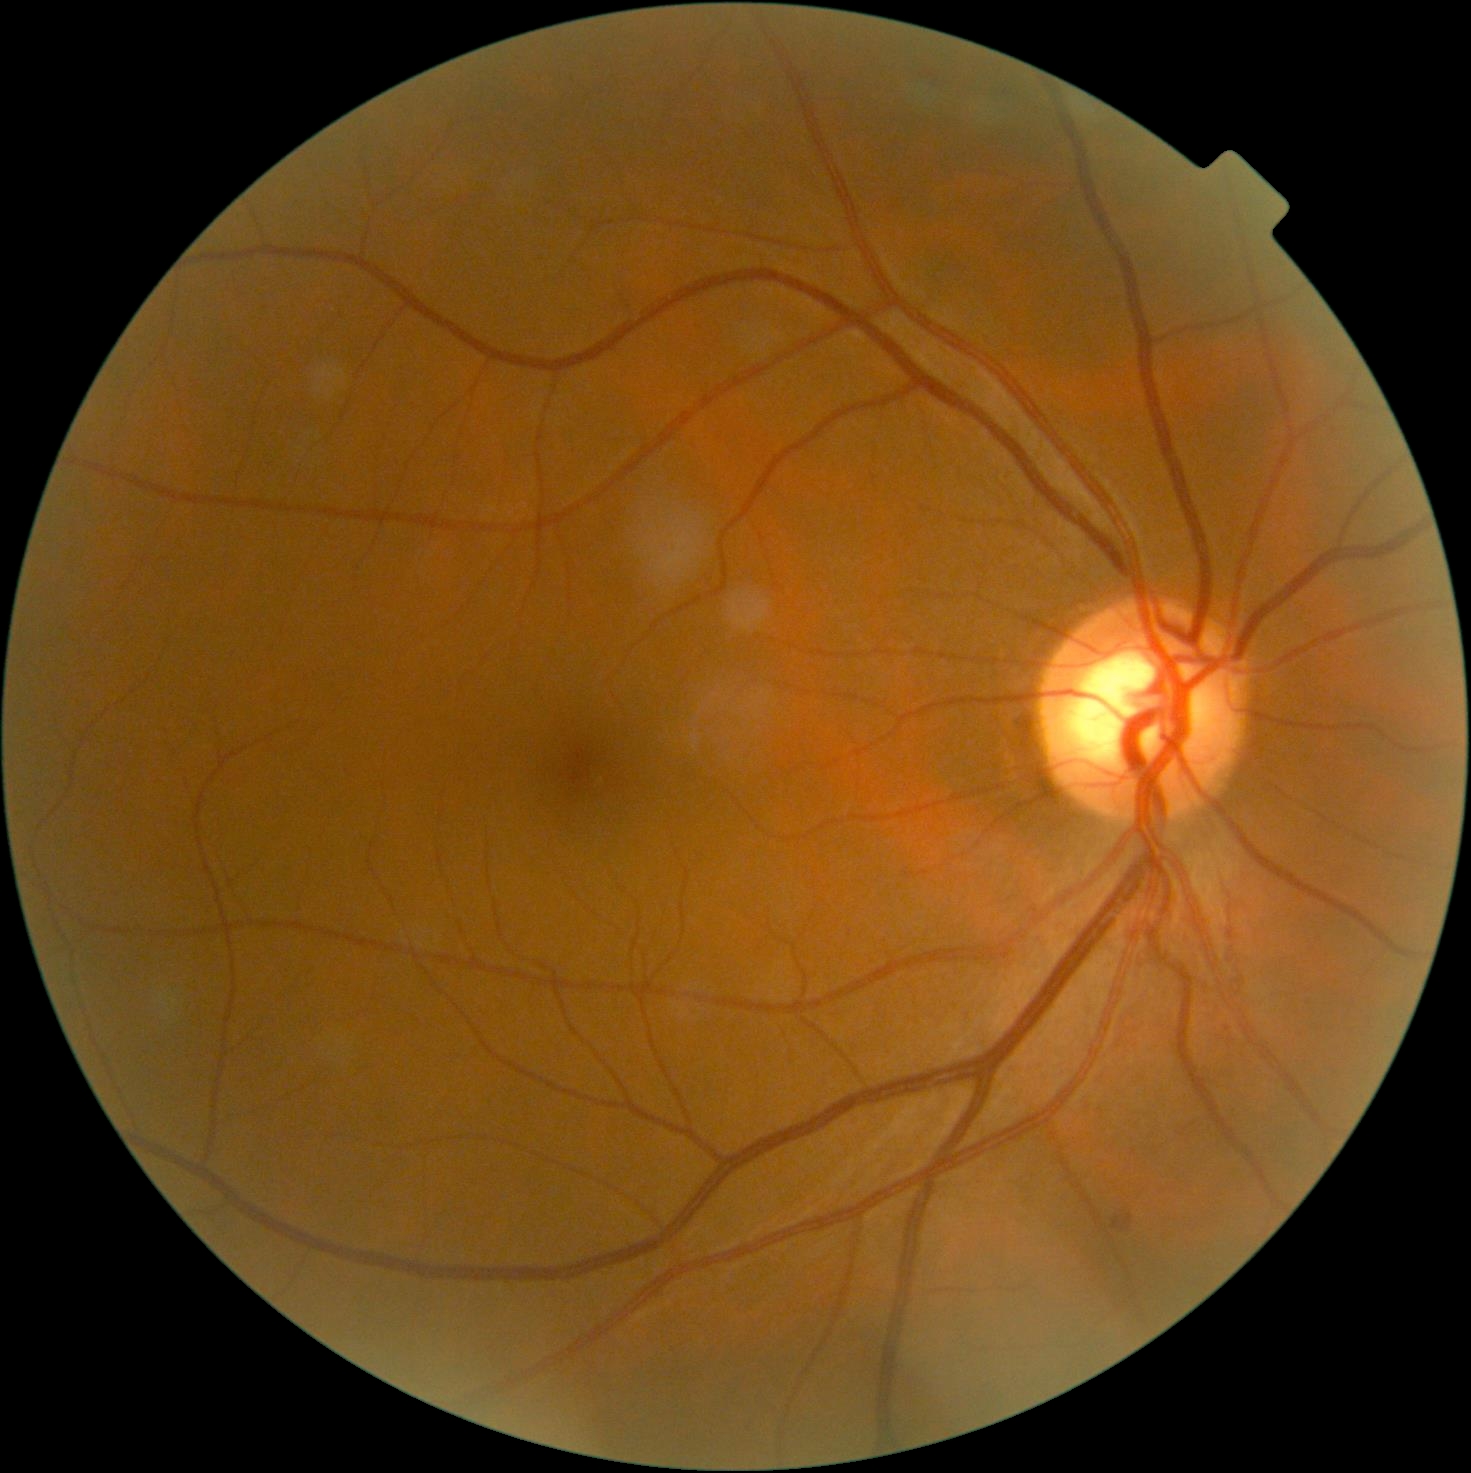
Retinopathy is 2/4.